Infant wide-field fundus photograph. Acquired on the Phoenix ICON:
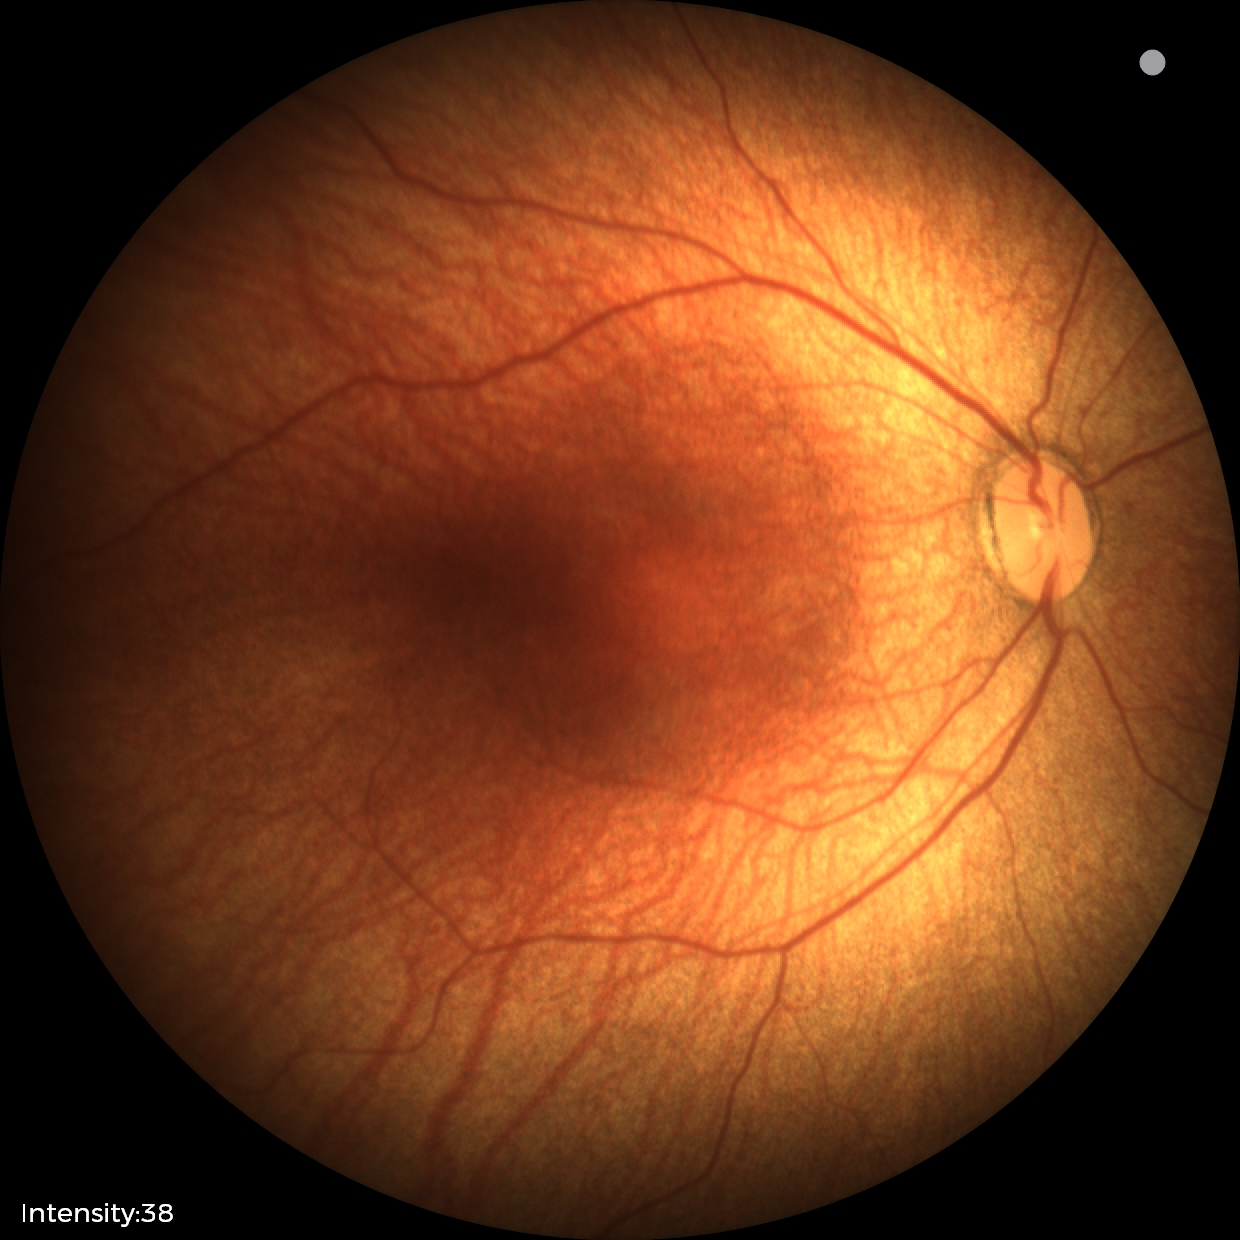 Screening examination consistent with status post ROP.
Without plus disease.